45° field of view:
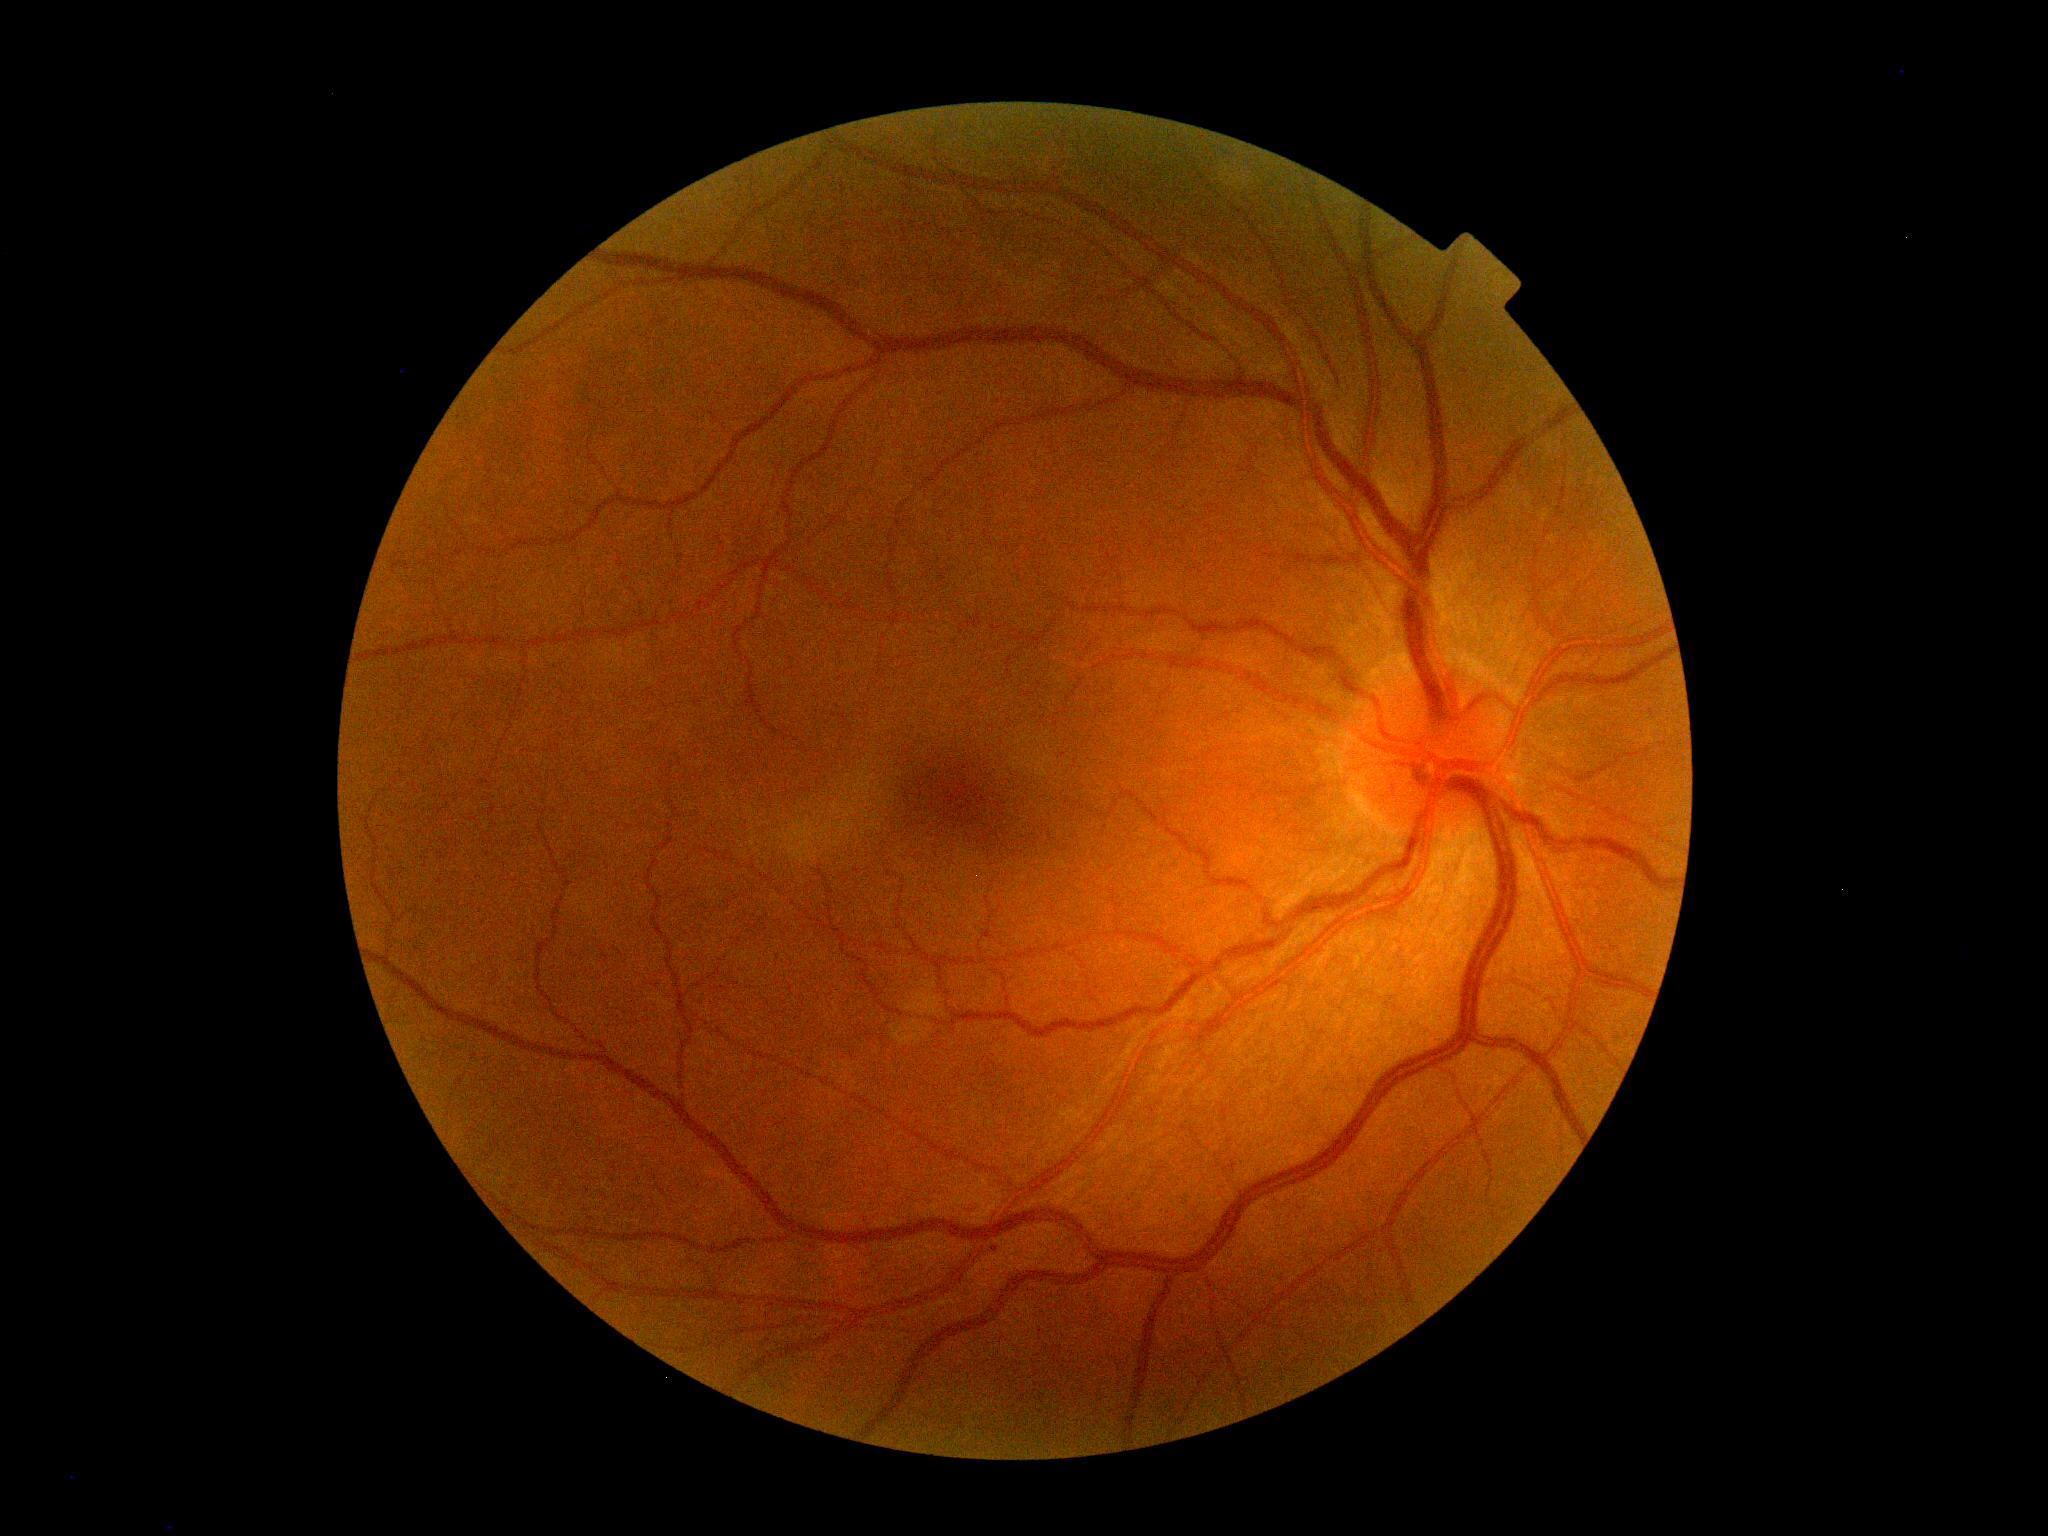

Retinopathy grade is 0 (no apparent retinopathy).